Non-mydriatic fundus camera — 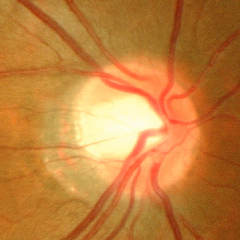

Showing no signs of glaucoma.